Portable fundus photograph: 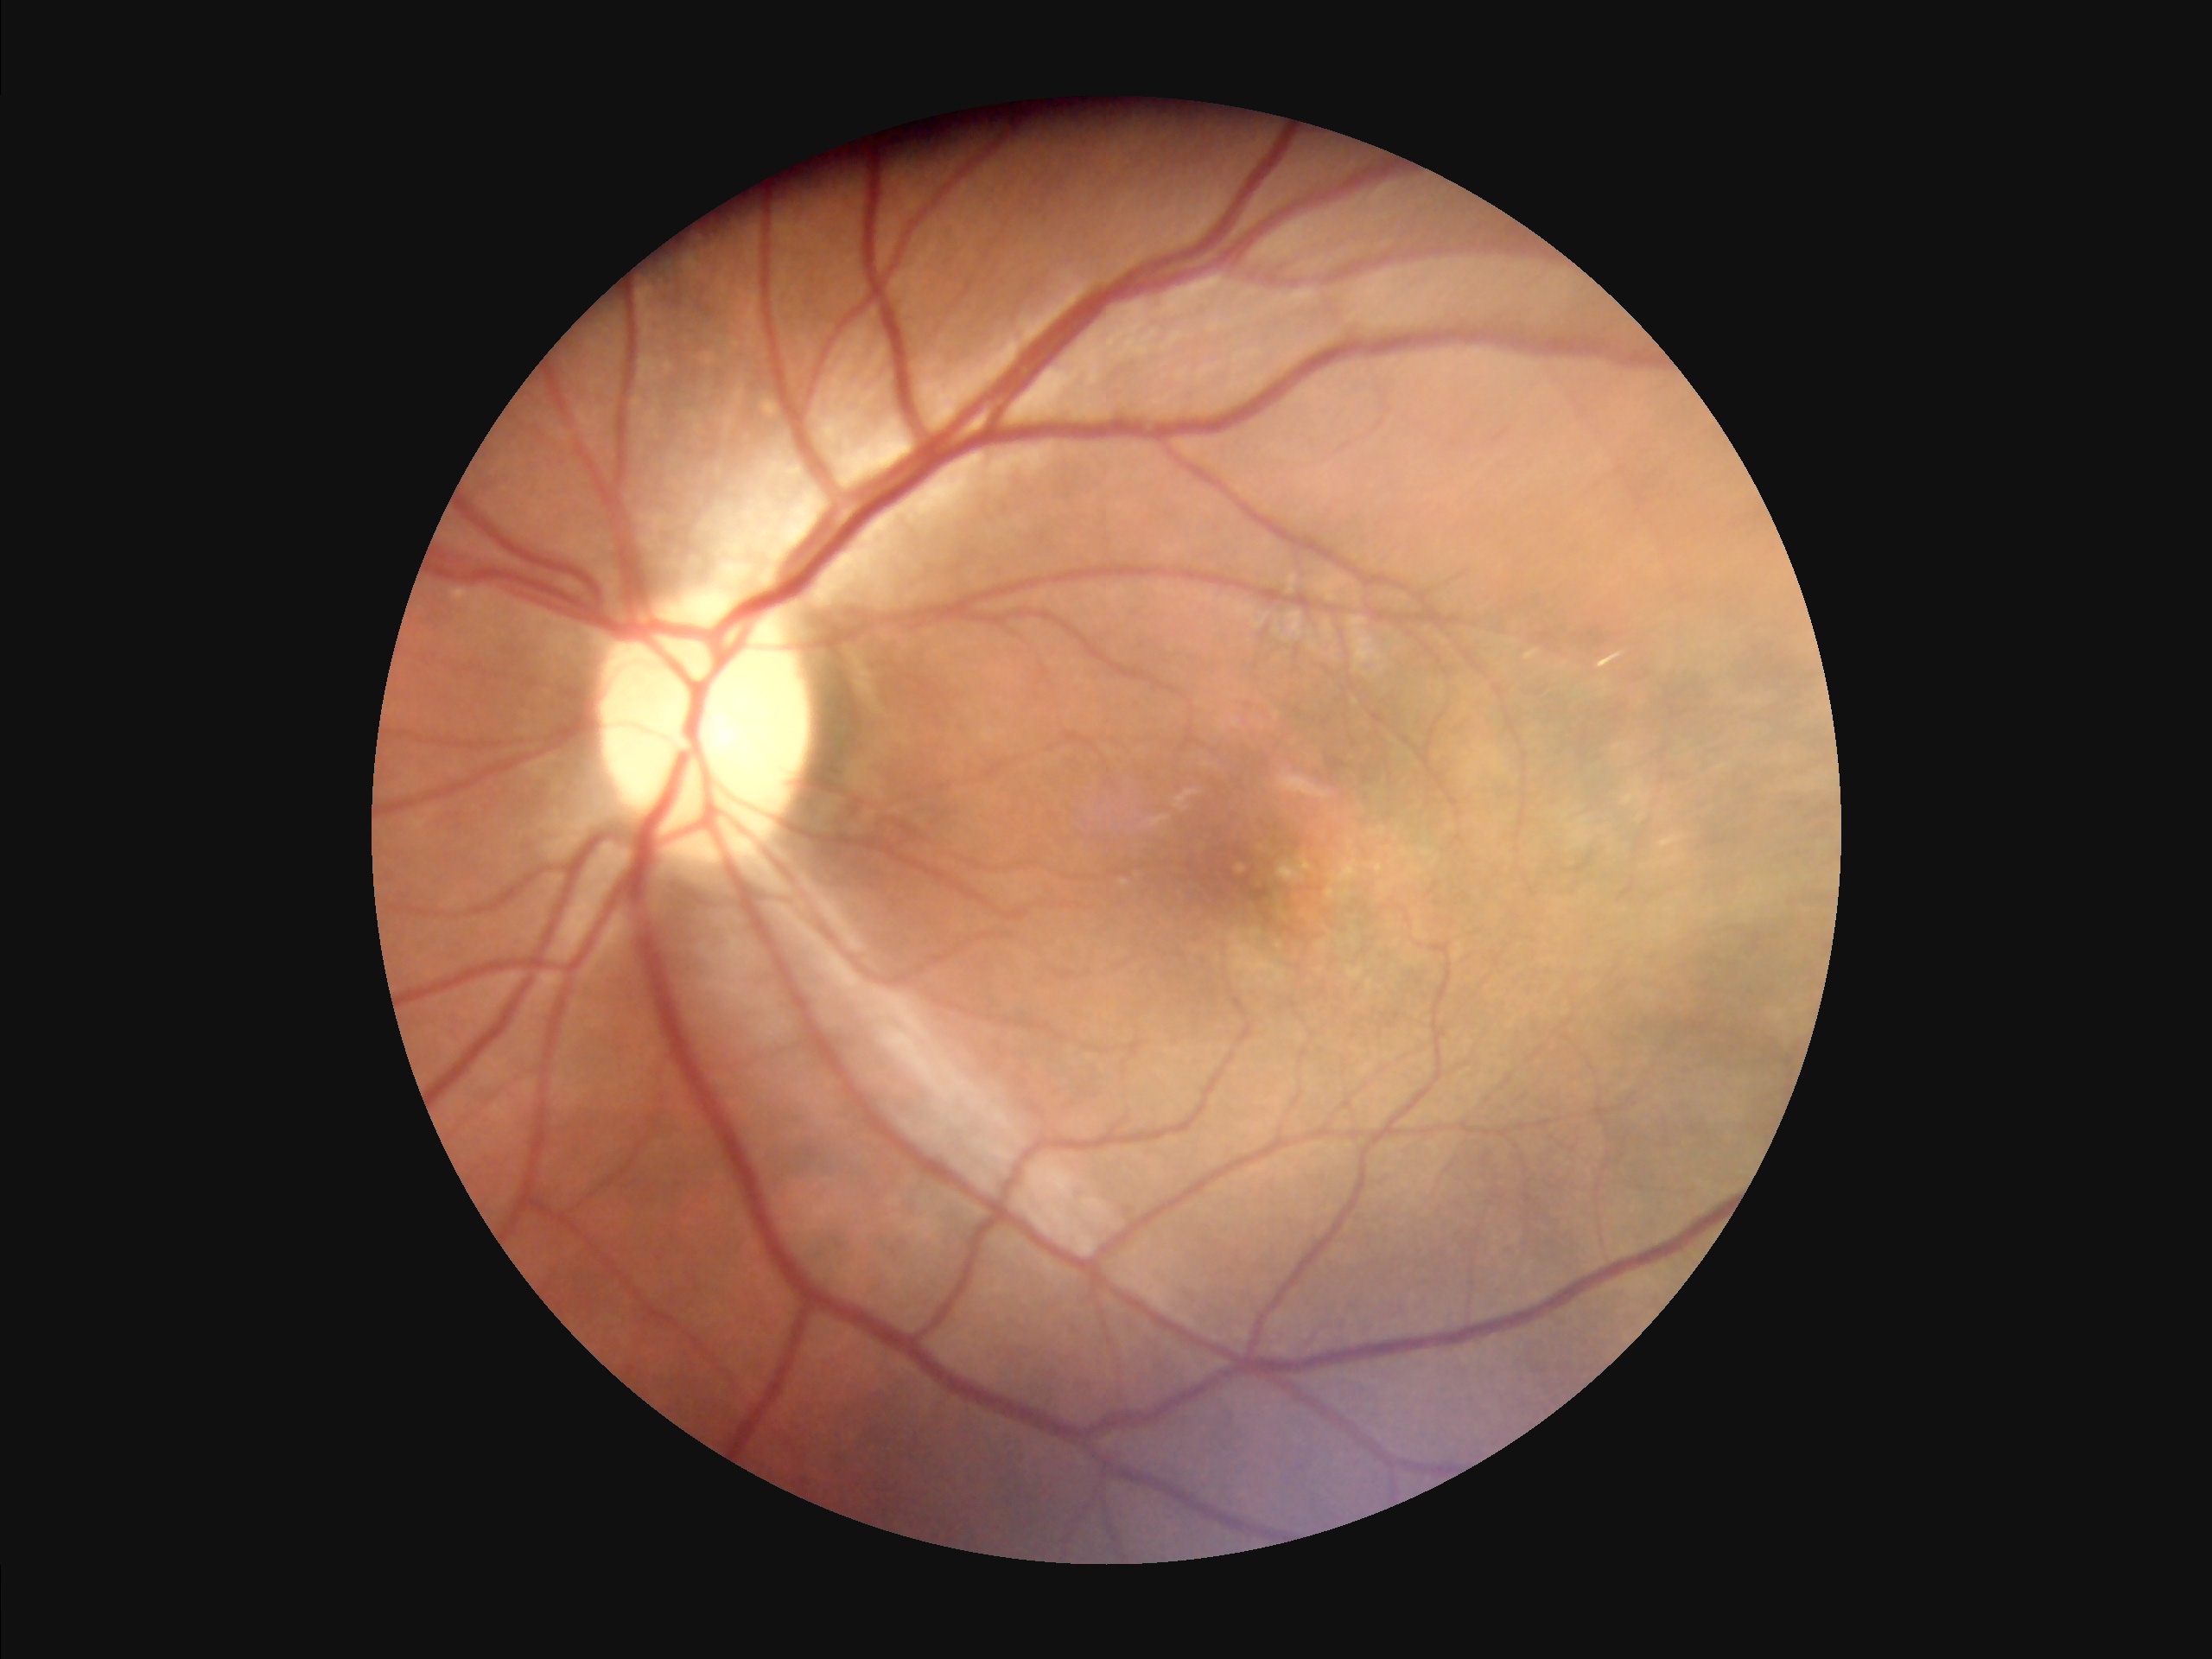 Image quality assessment:
- contrast: satisfactory
- focus: good
- overall: adequate